Infant wide-field retinal image. Captured with the Clarity RetCam 3 (130° field of view): 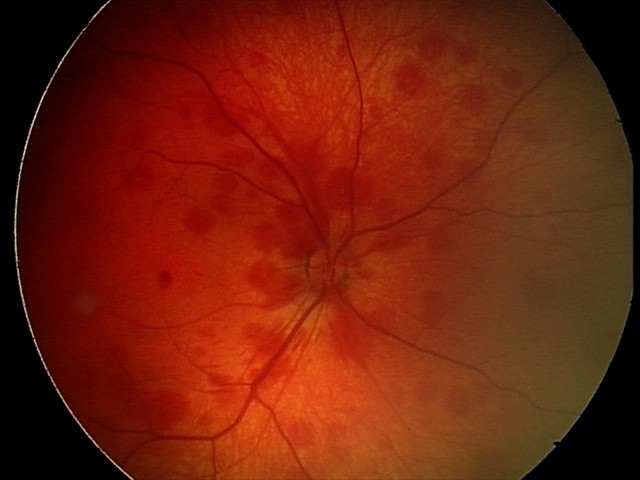
Screening examination consistent with retinal hemorrhages.